2352x1568px, FOV: 45 degrees
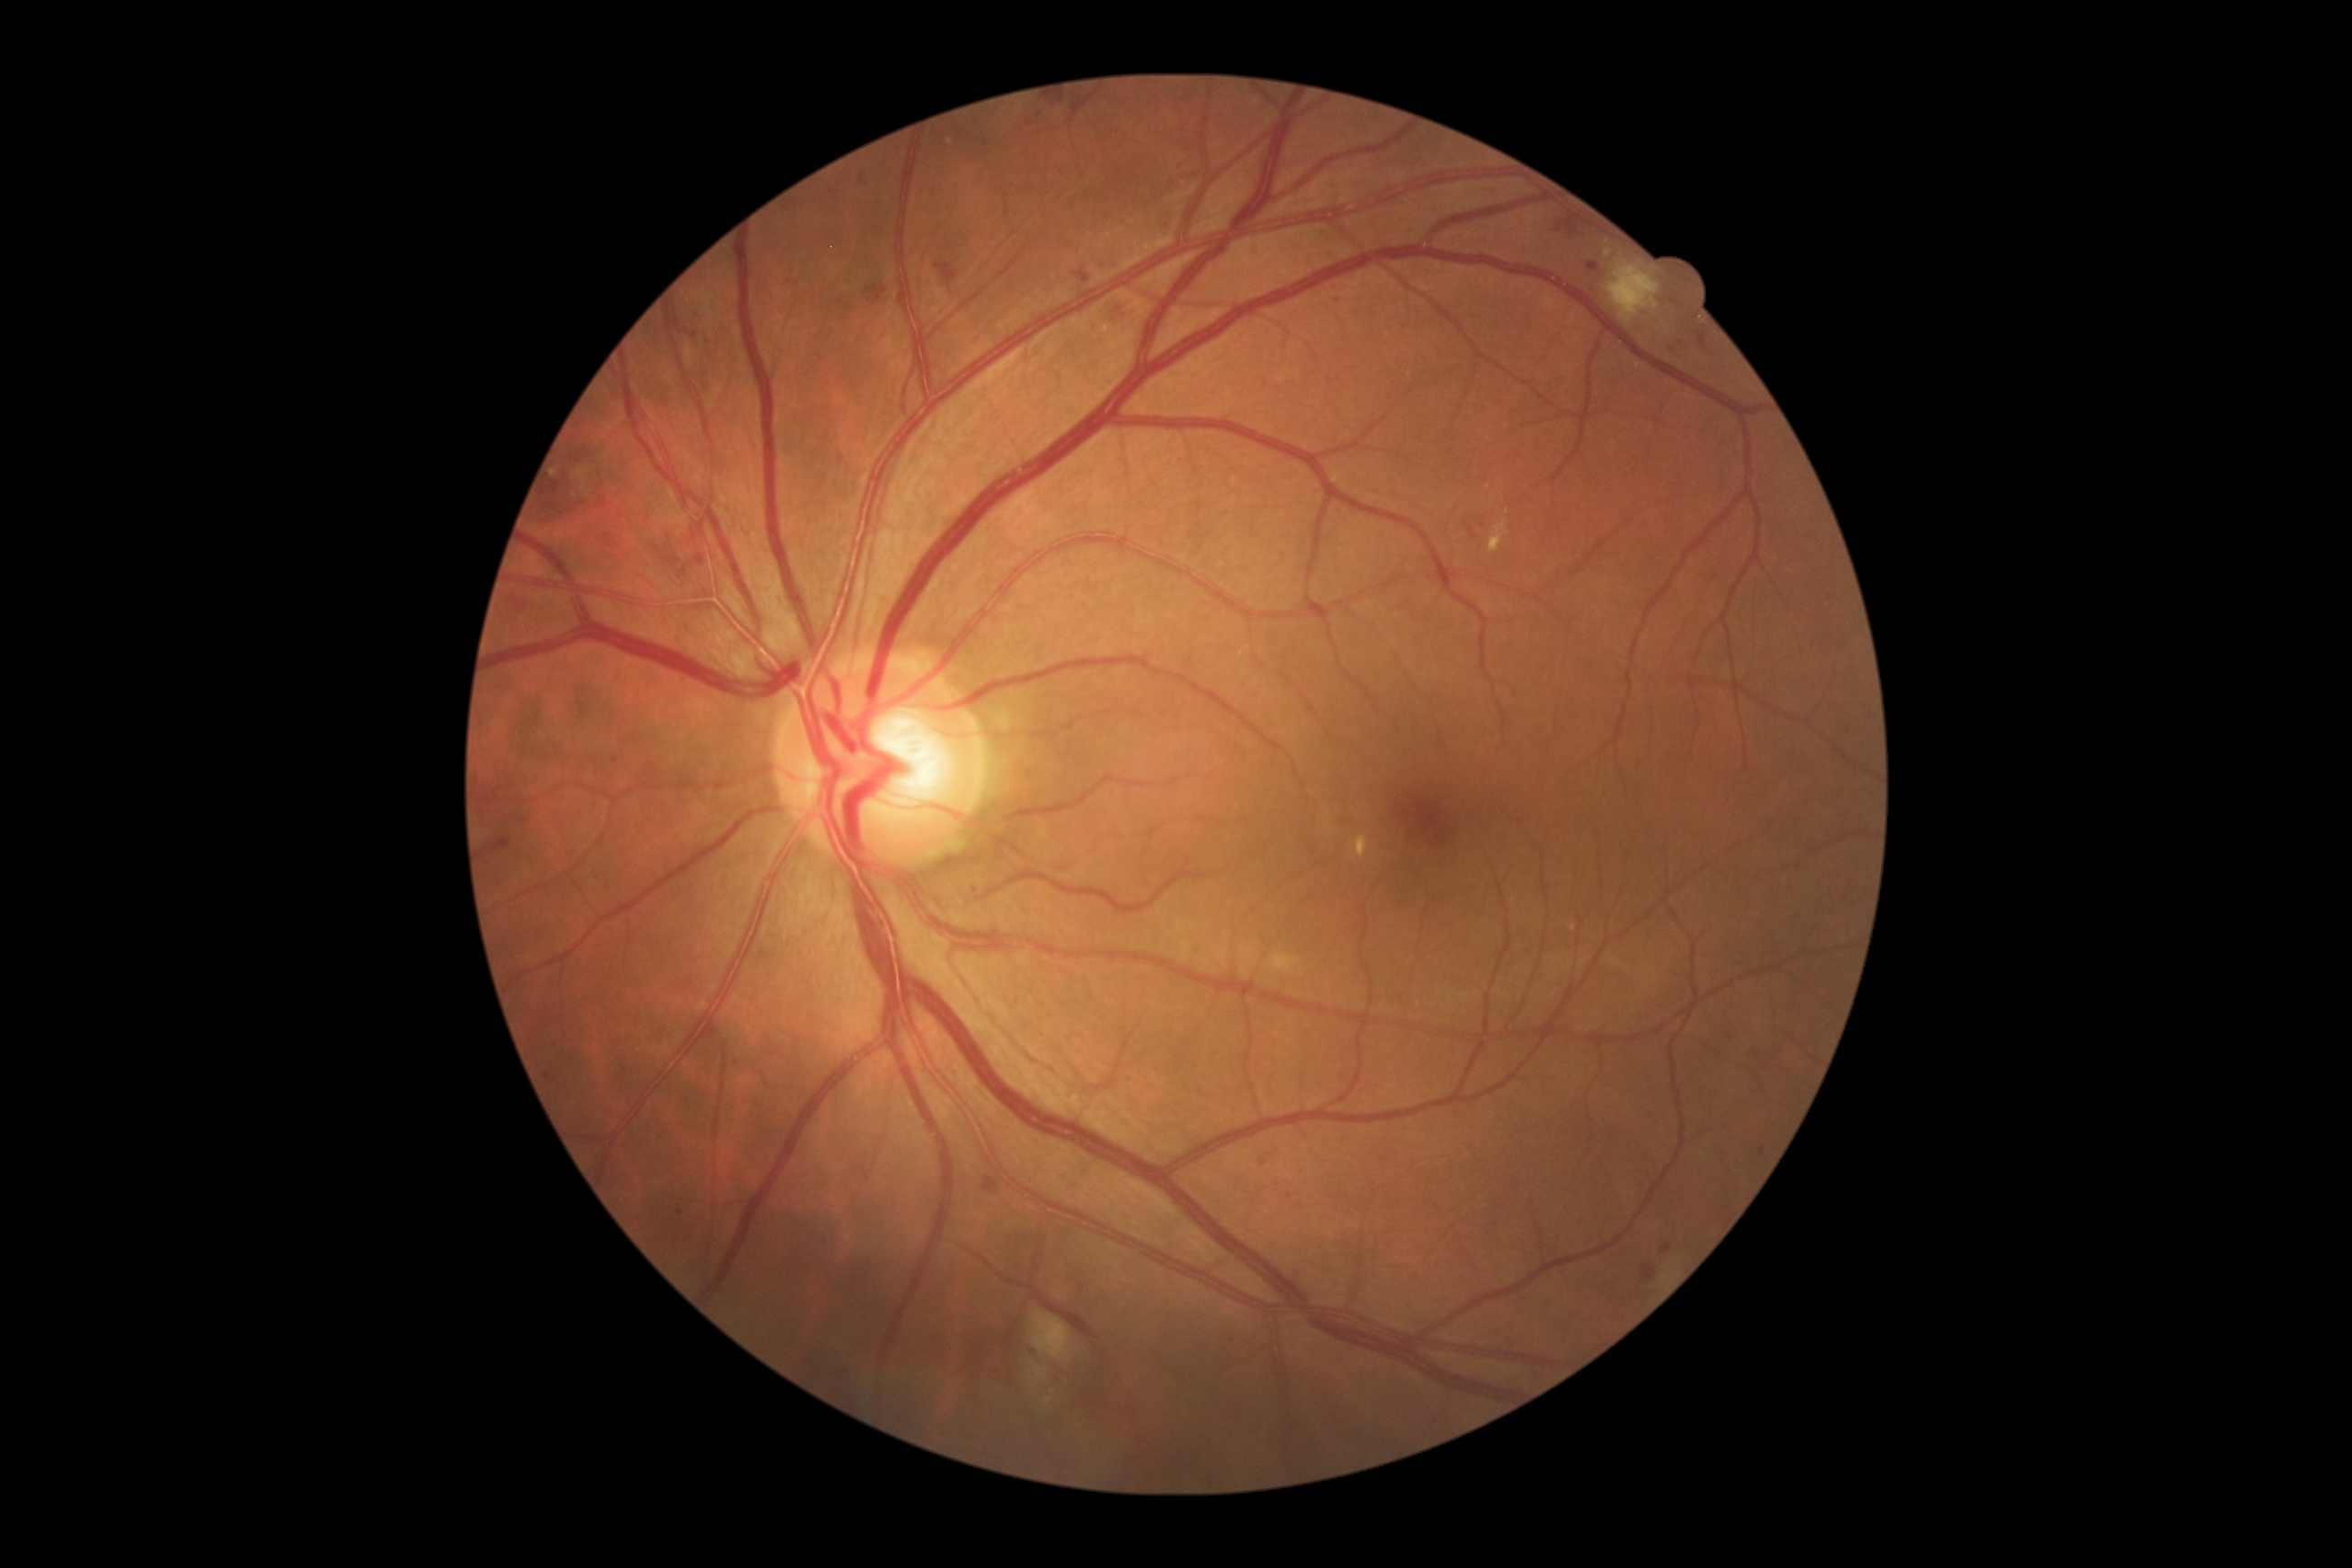
partial: true
dr_grade: 2
dr_grade_name: moderate NPDR
lesions:
  ma:
    - [left=972, top=888, right=981, bottom=899]
    - [left=509, top=596, right=527, bottom=614]
    - [left=1493, top=184, right=1502, bottom=201]
    - [left=1173, top=161, right=1184, bottom=166]
    - [left=491, top=839, right=513, bottom=854]
    - [left=865, top=284, right=887, bottom=302]
    - [left=1077, top=270, right=1090, bottom=284]
    - [left=1046, top=97, right=1070, bottom=106]
    - [left=1661, top=1244, right=1672, bottom=1257]
    - [left=1026, top=121, right=1035, bottom=128]
    - [left=676, top=318, right=680, bottom=329]
    - [left=600, top=500, right=609, bottom=509]
  ma_small:
    - [870, 300]
    - [1289, 1197]
    - [1683, 344]
    - [524, 822]
    - [1482, 526]
    - [1757, 1055]